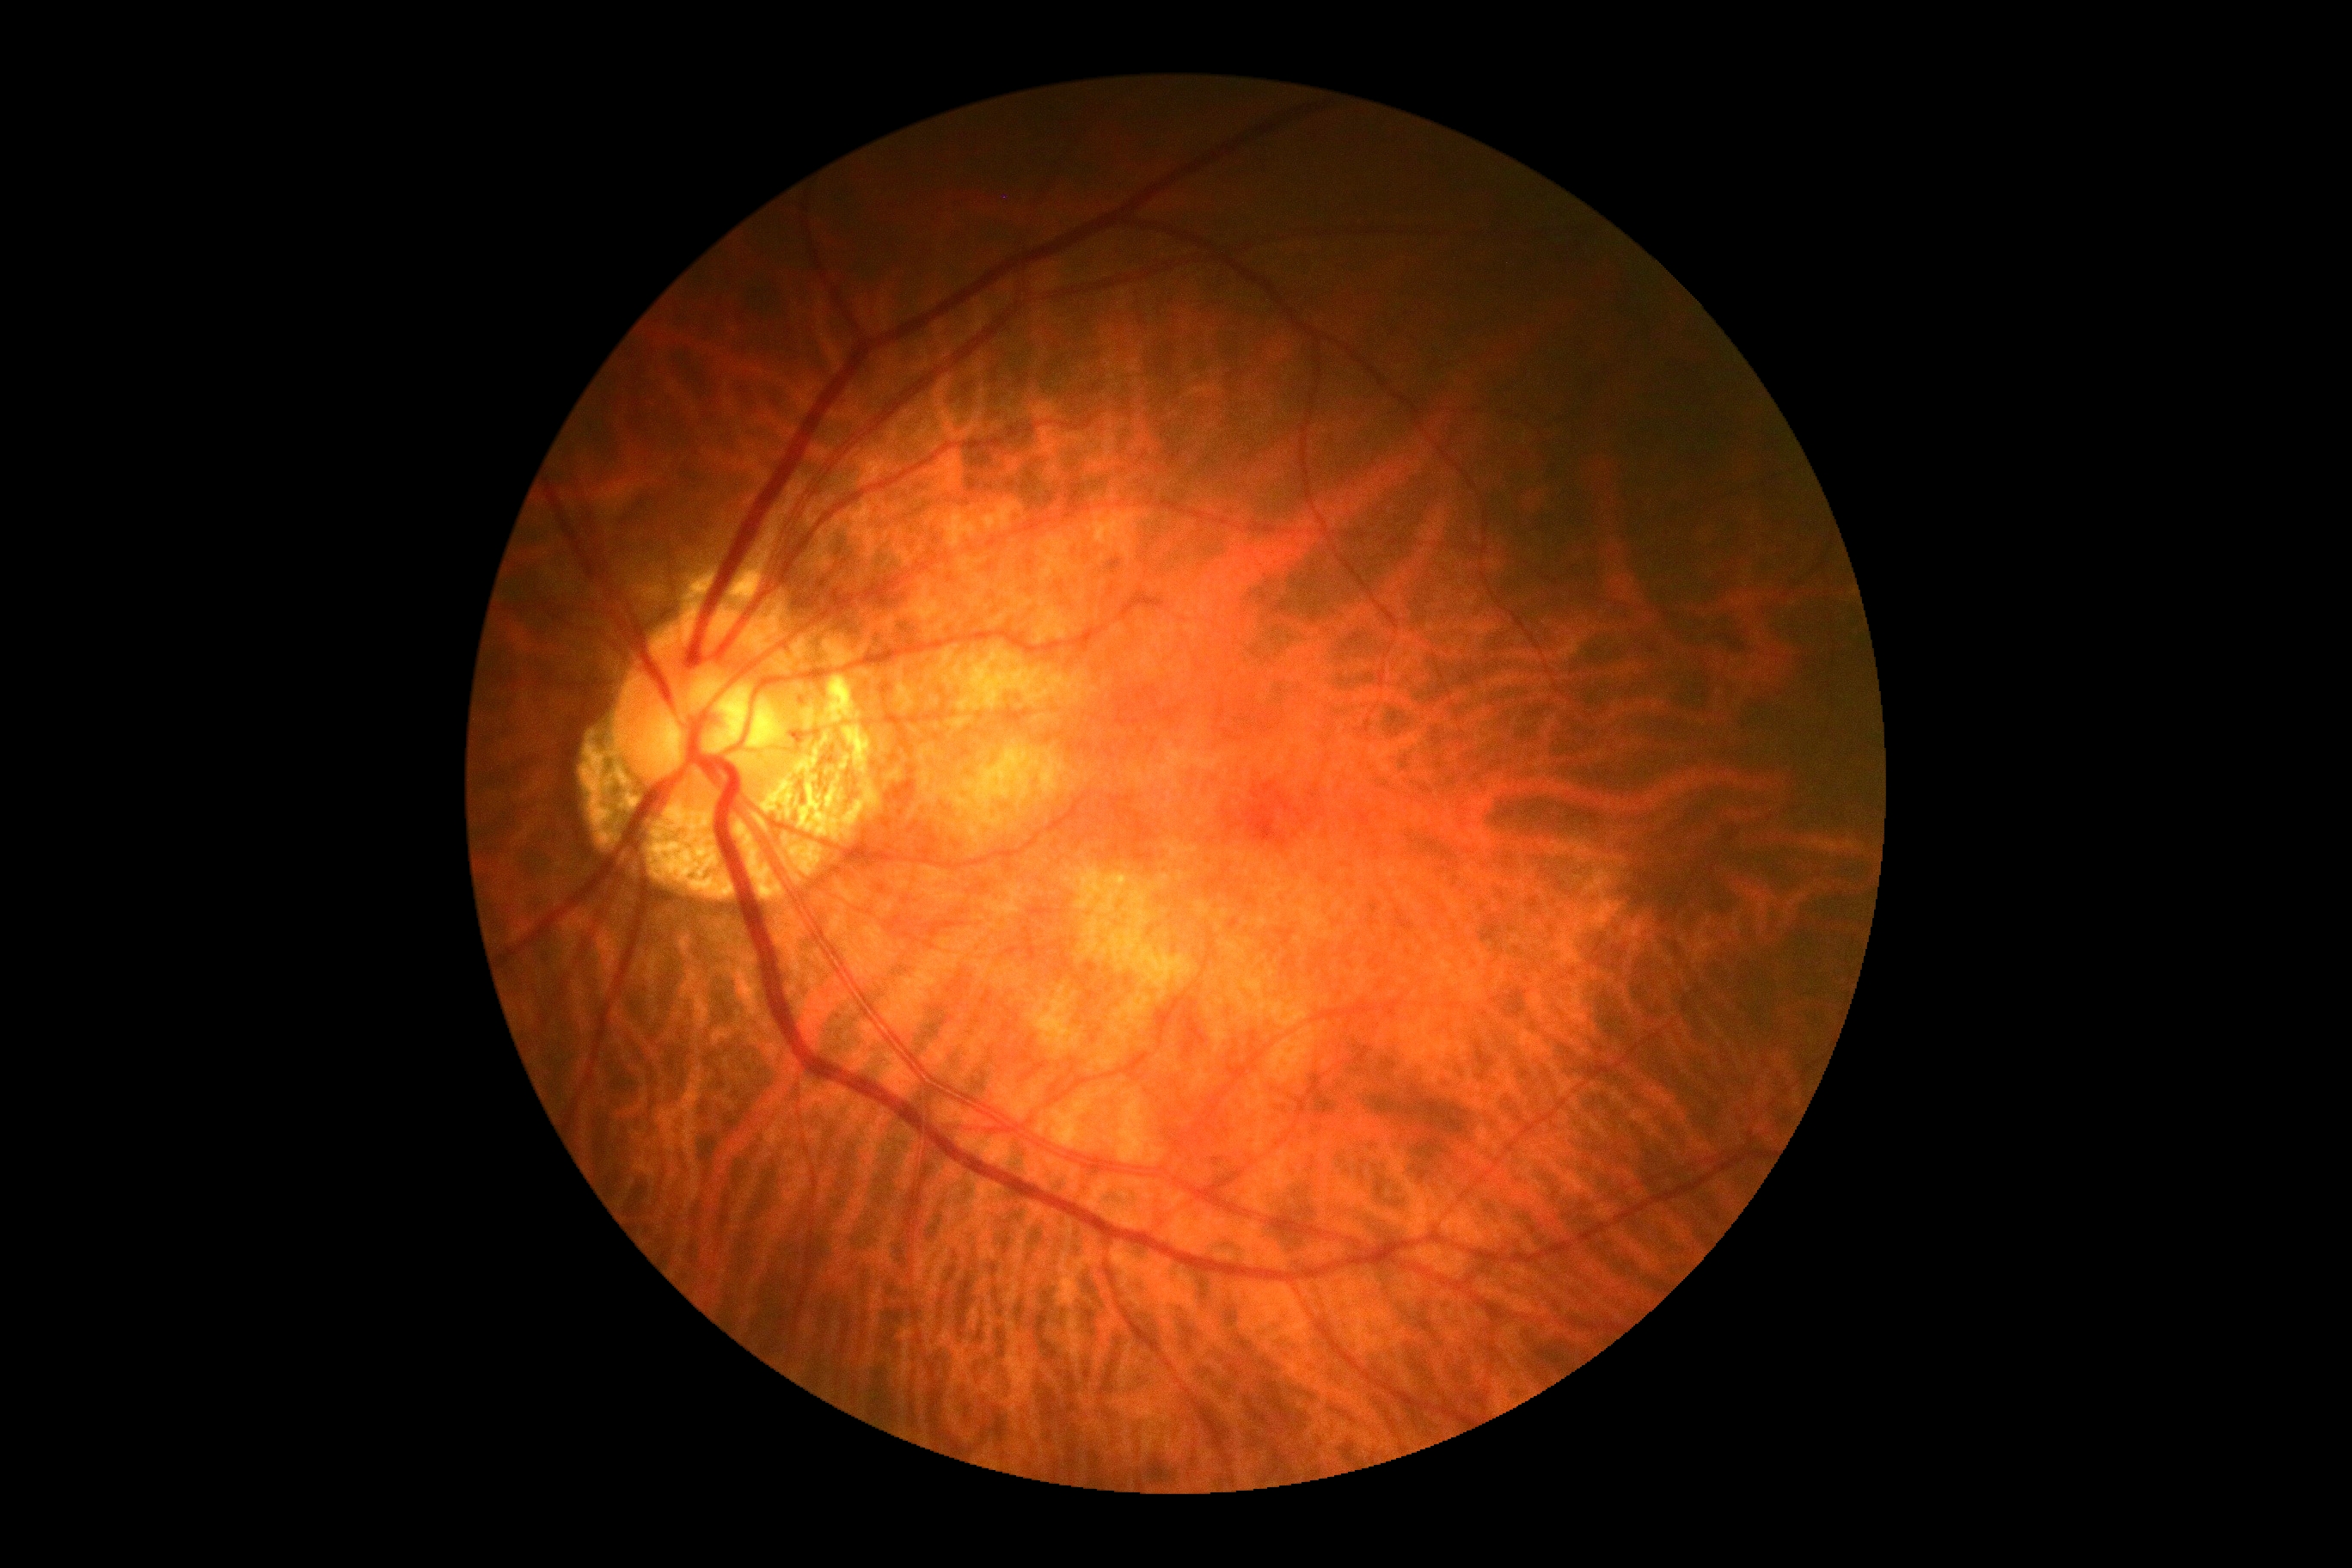 Diabetic retinopathy (DR) is no apparent diabetic retinopathy (grade 0).